Fundus photo: 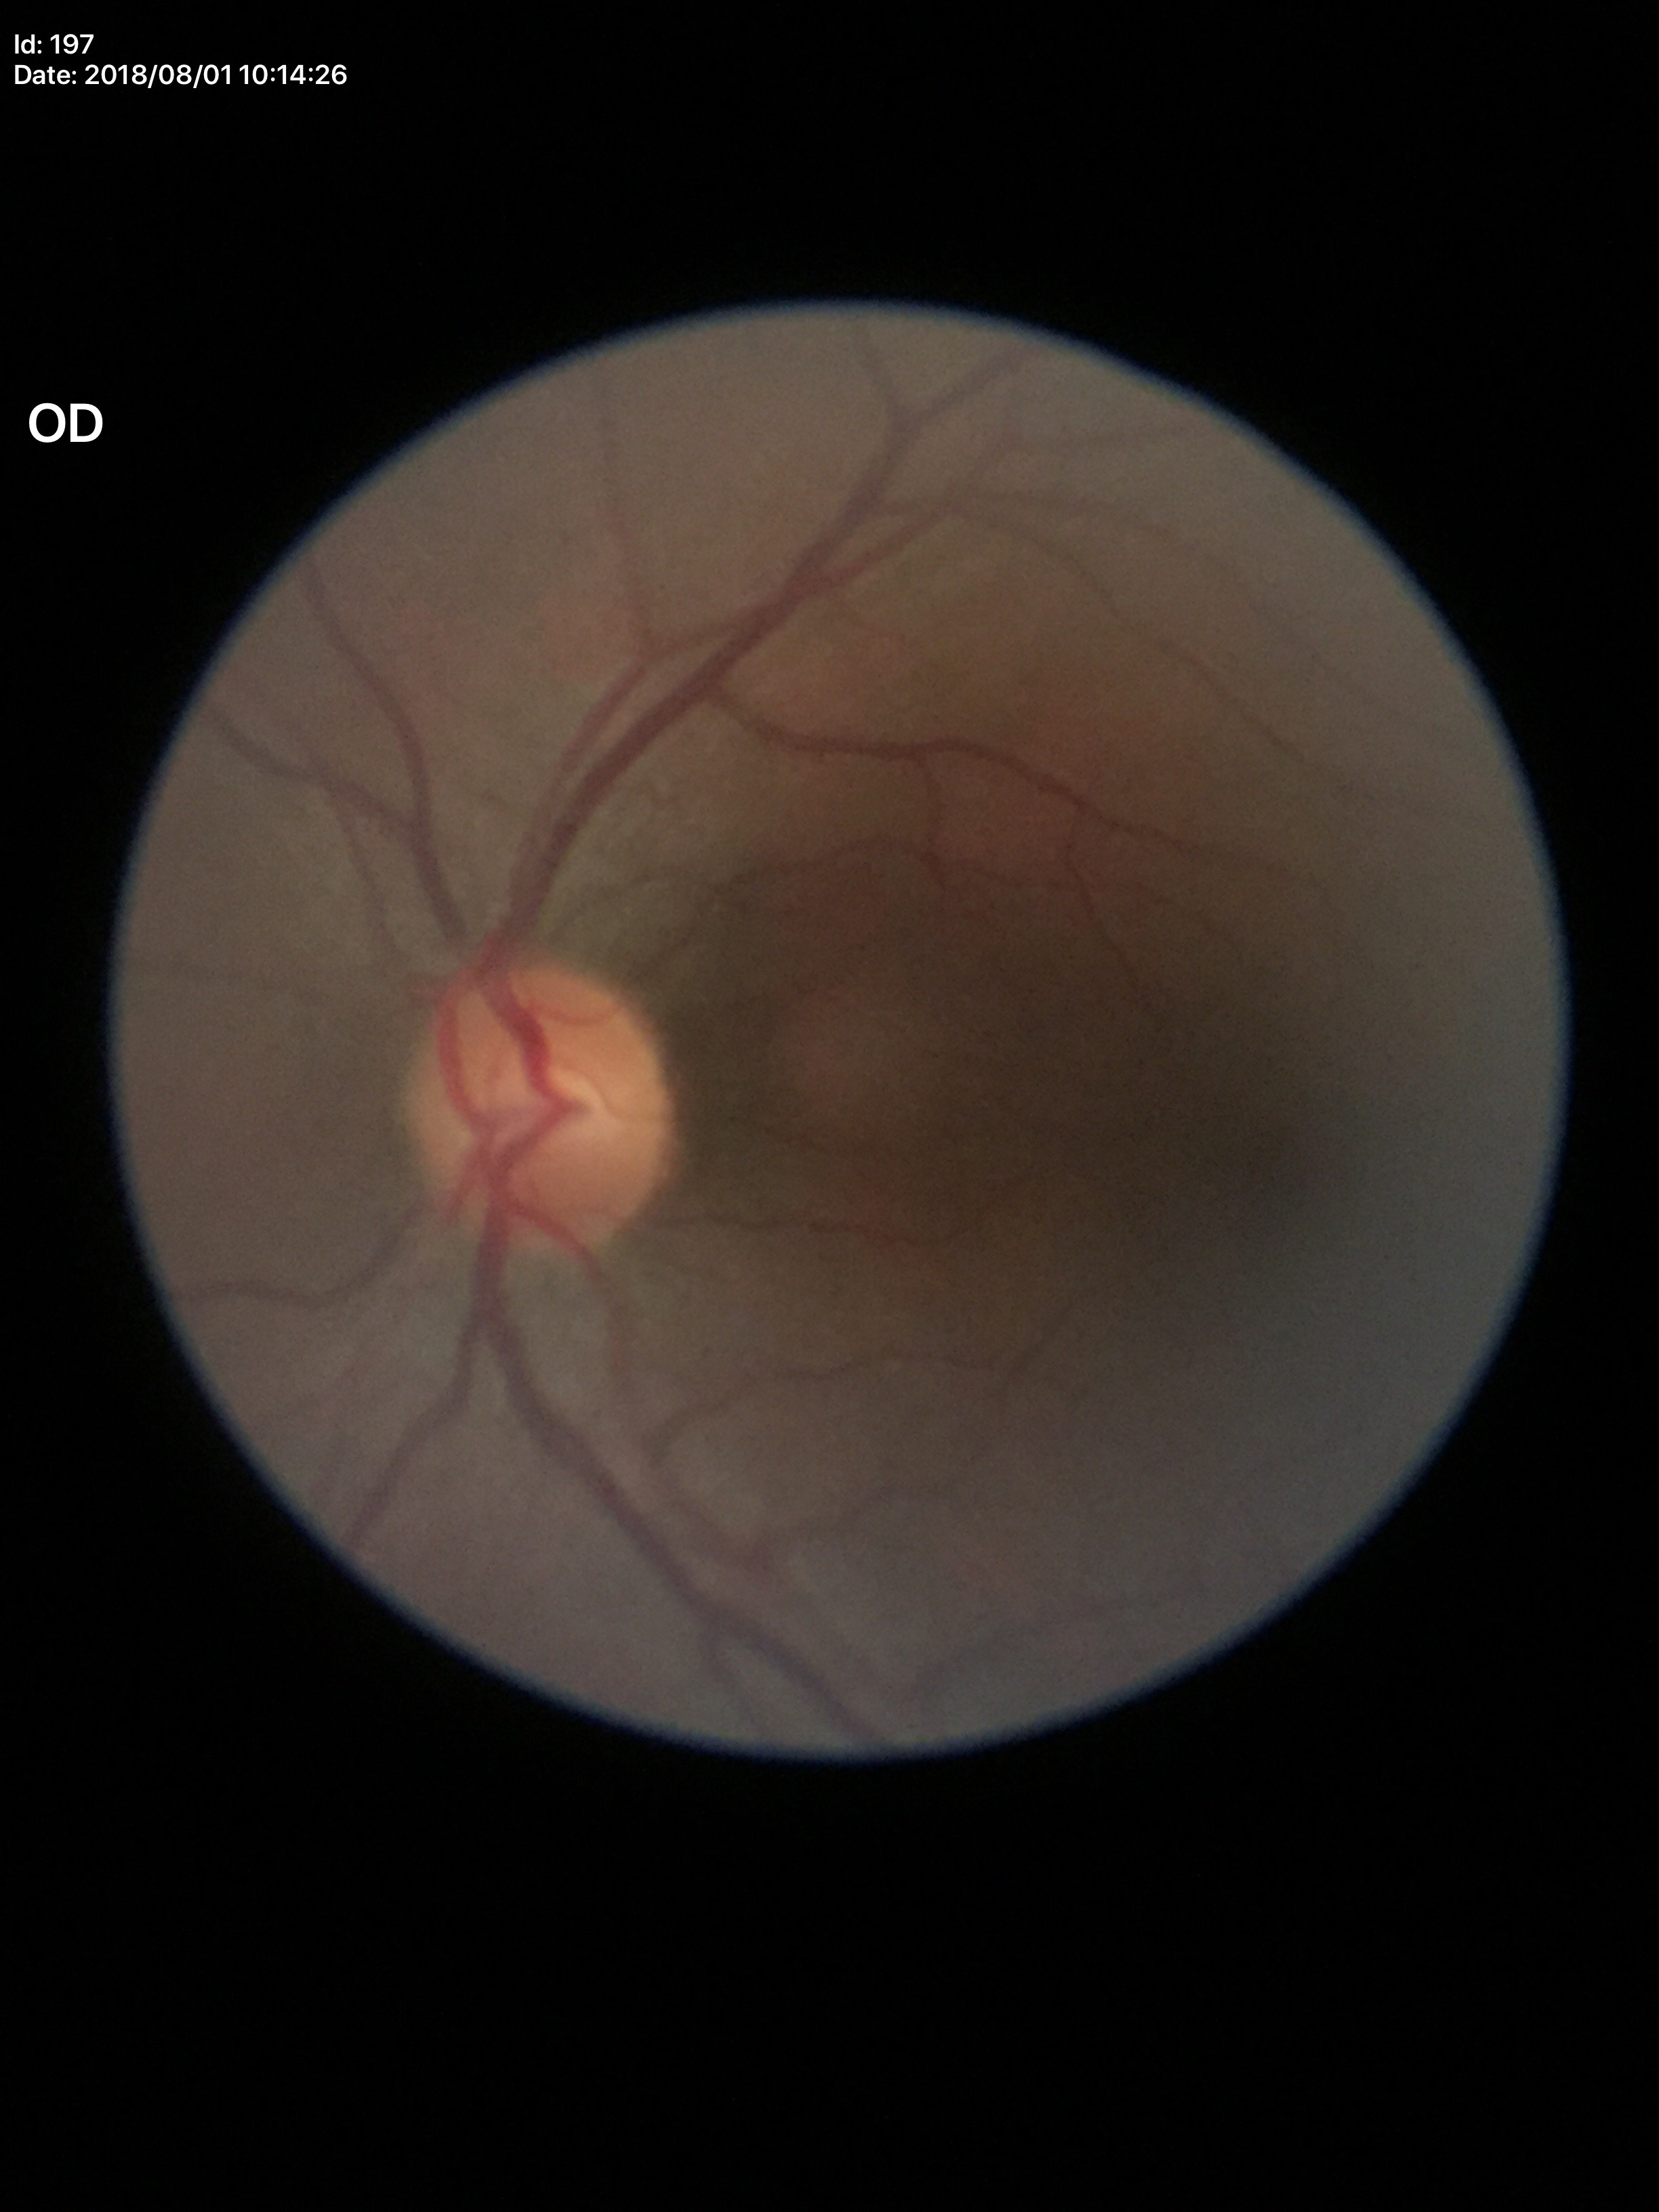
Glaucoma decision=no suspicious findings
vertical cup-disc ratio=0.47
horizontal cup-disc ratio=0.56